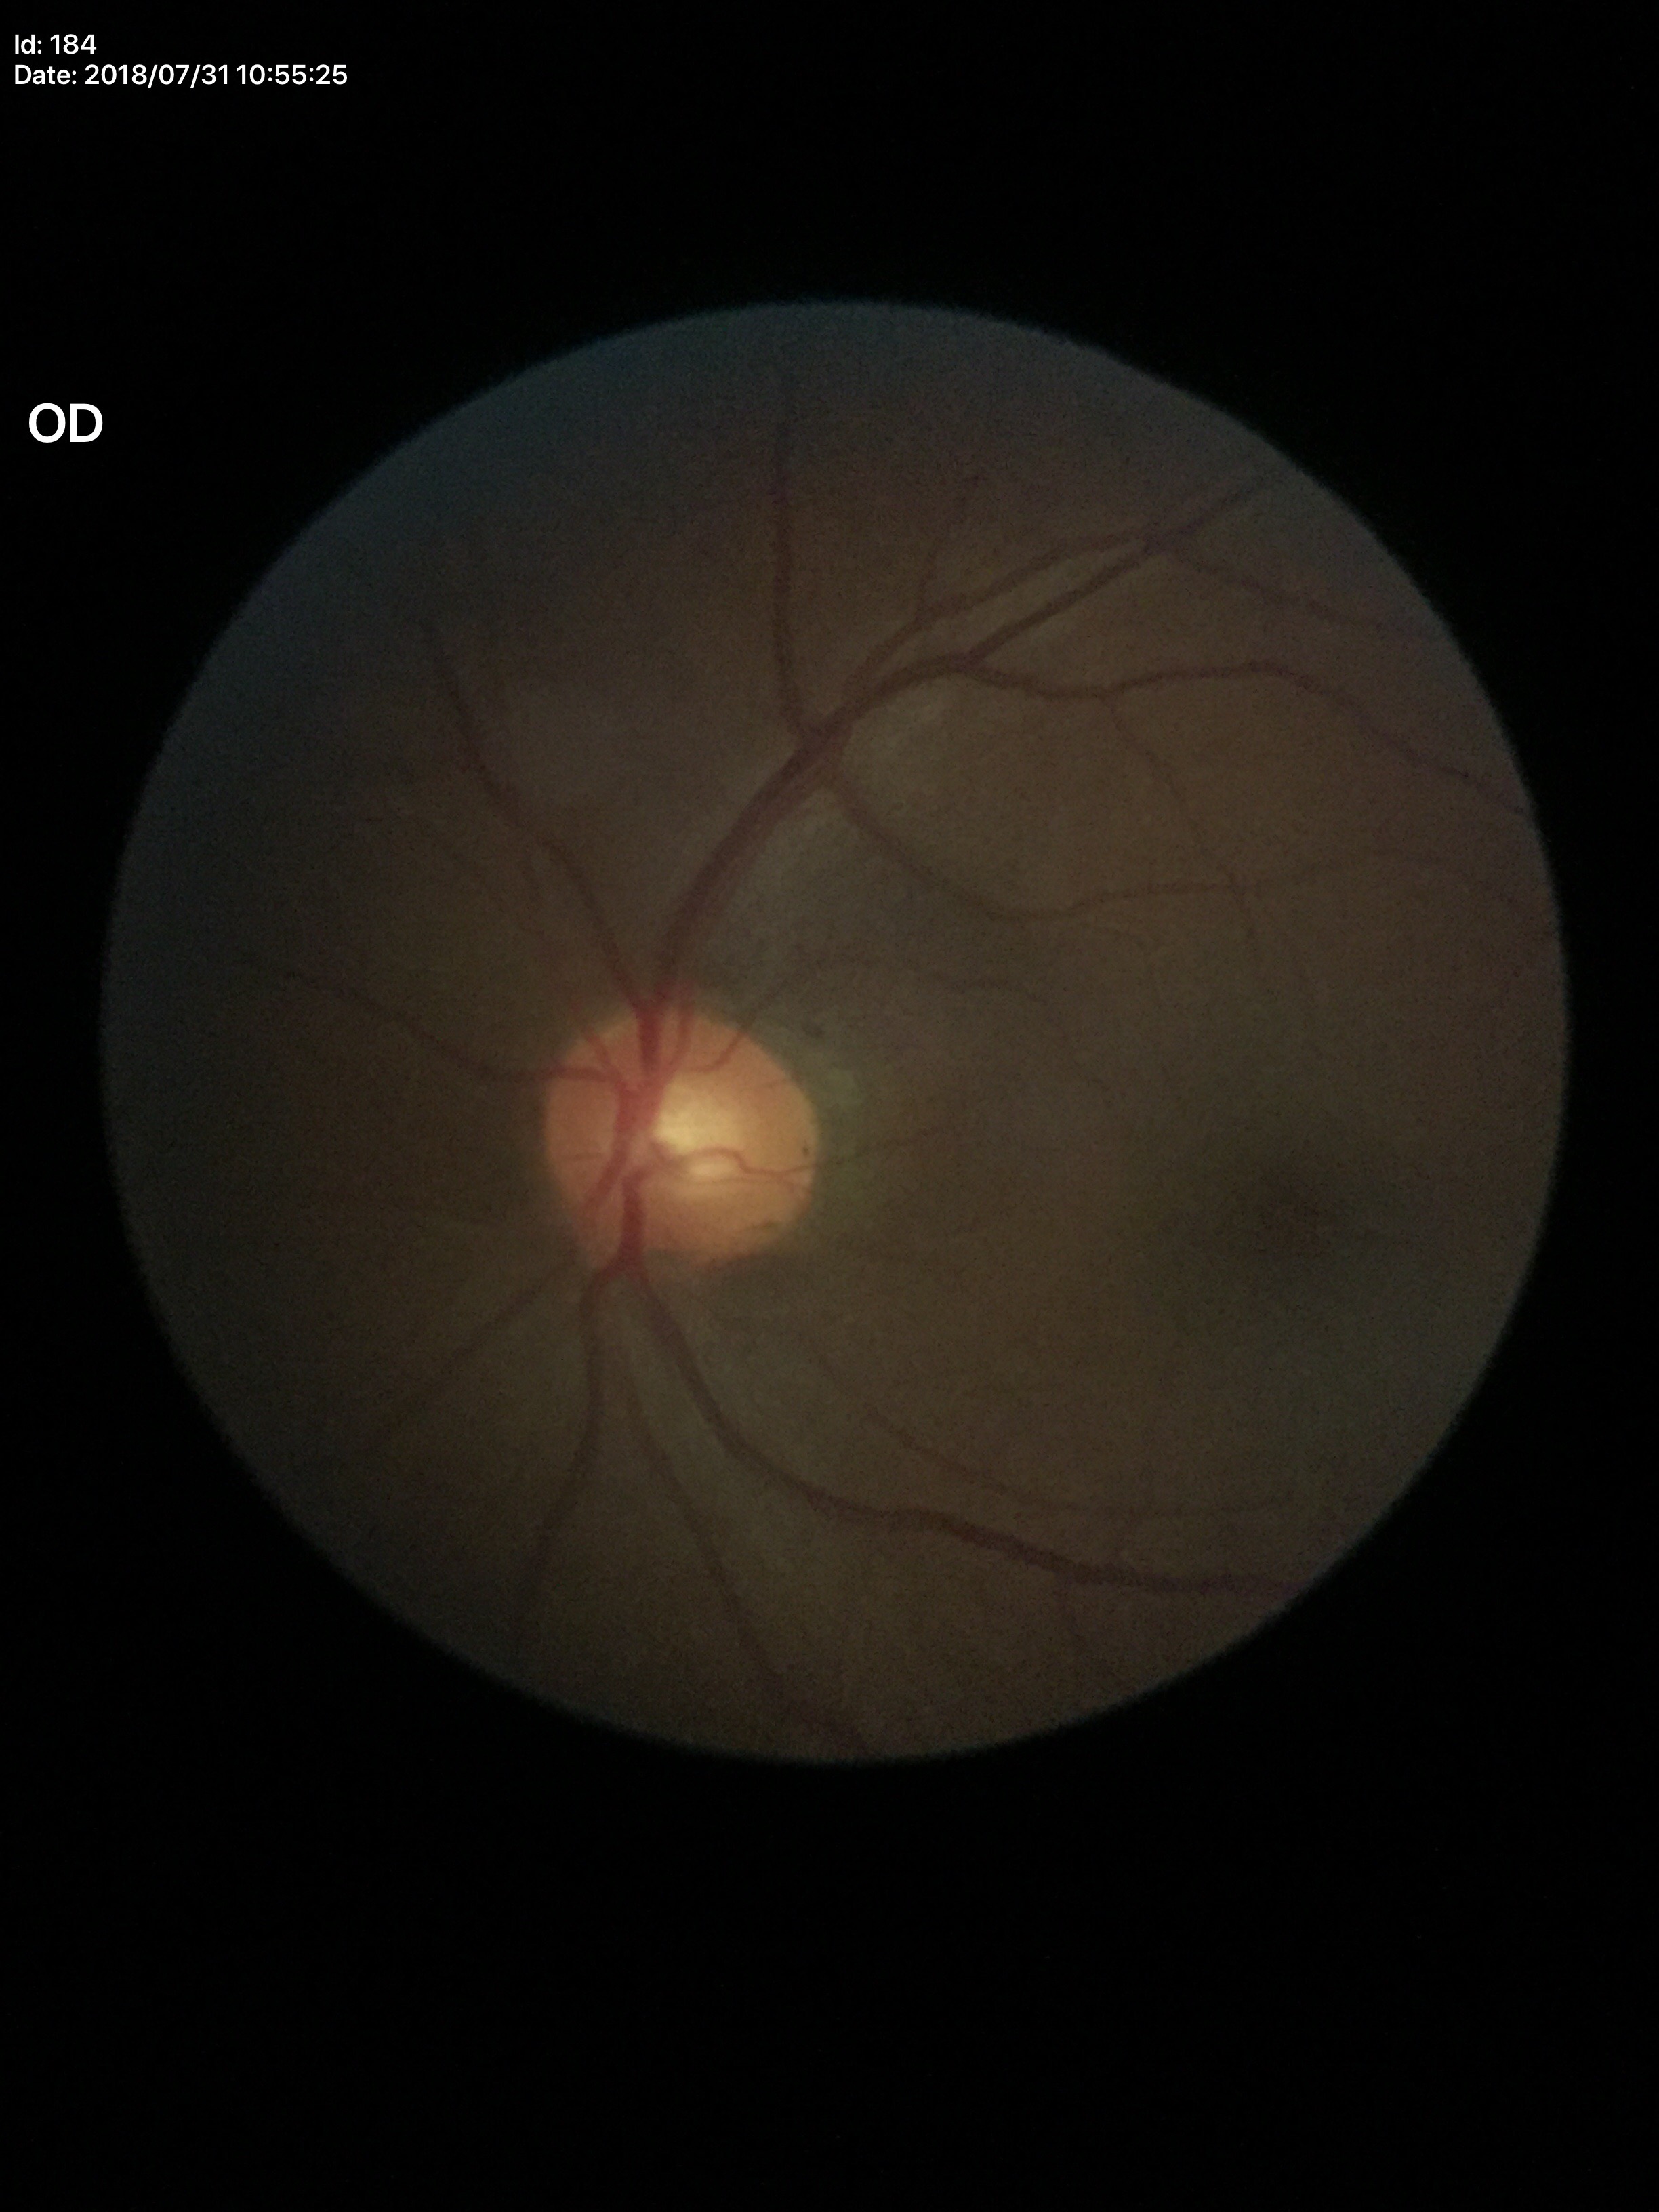
Optic disc analysis:
- area C/D ratio — 0.27
- Glaucoma assessment — no suspicious findings (one of five ophthalmologists flagged glaucoma suspect)
- vertical CDR — 0.53
- horizontal CDR — 0.52